45-degree field of view.
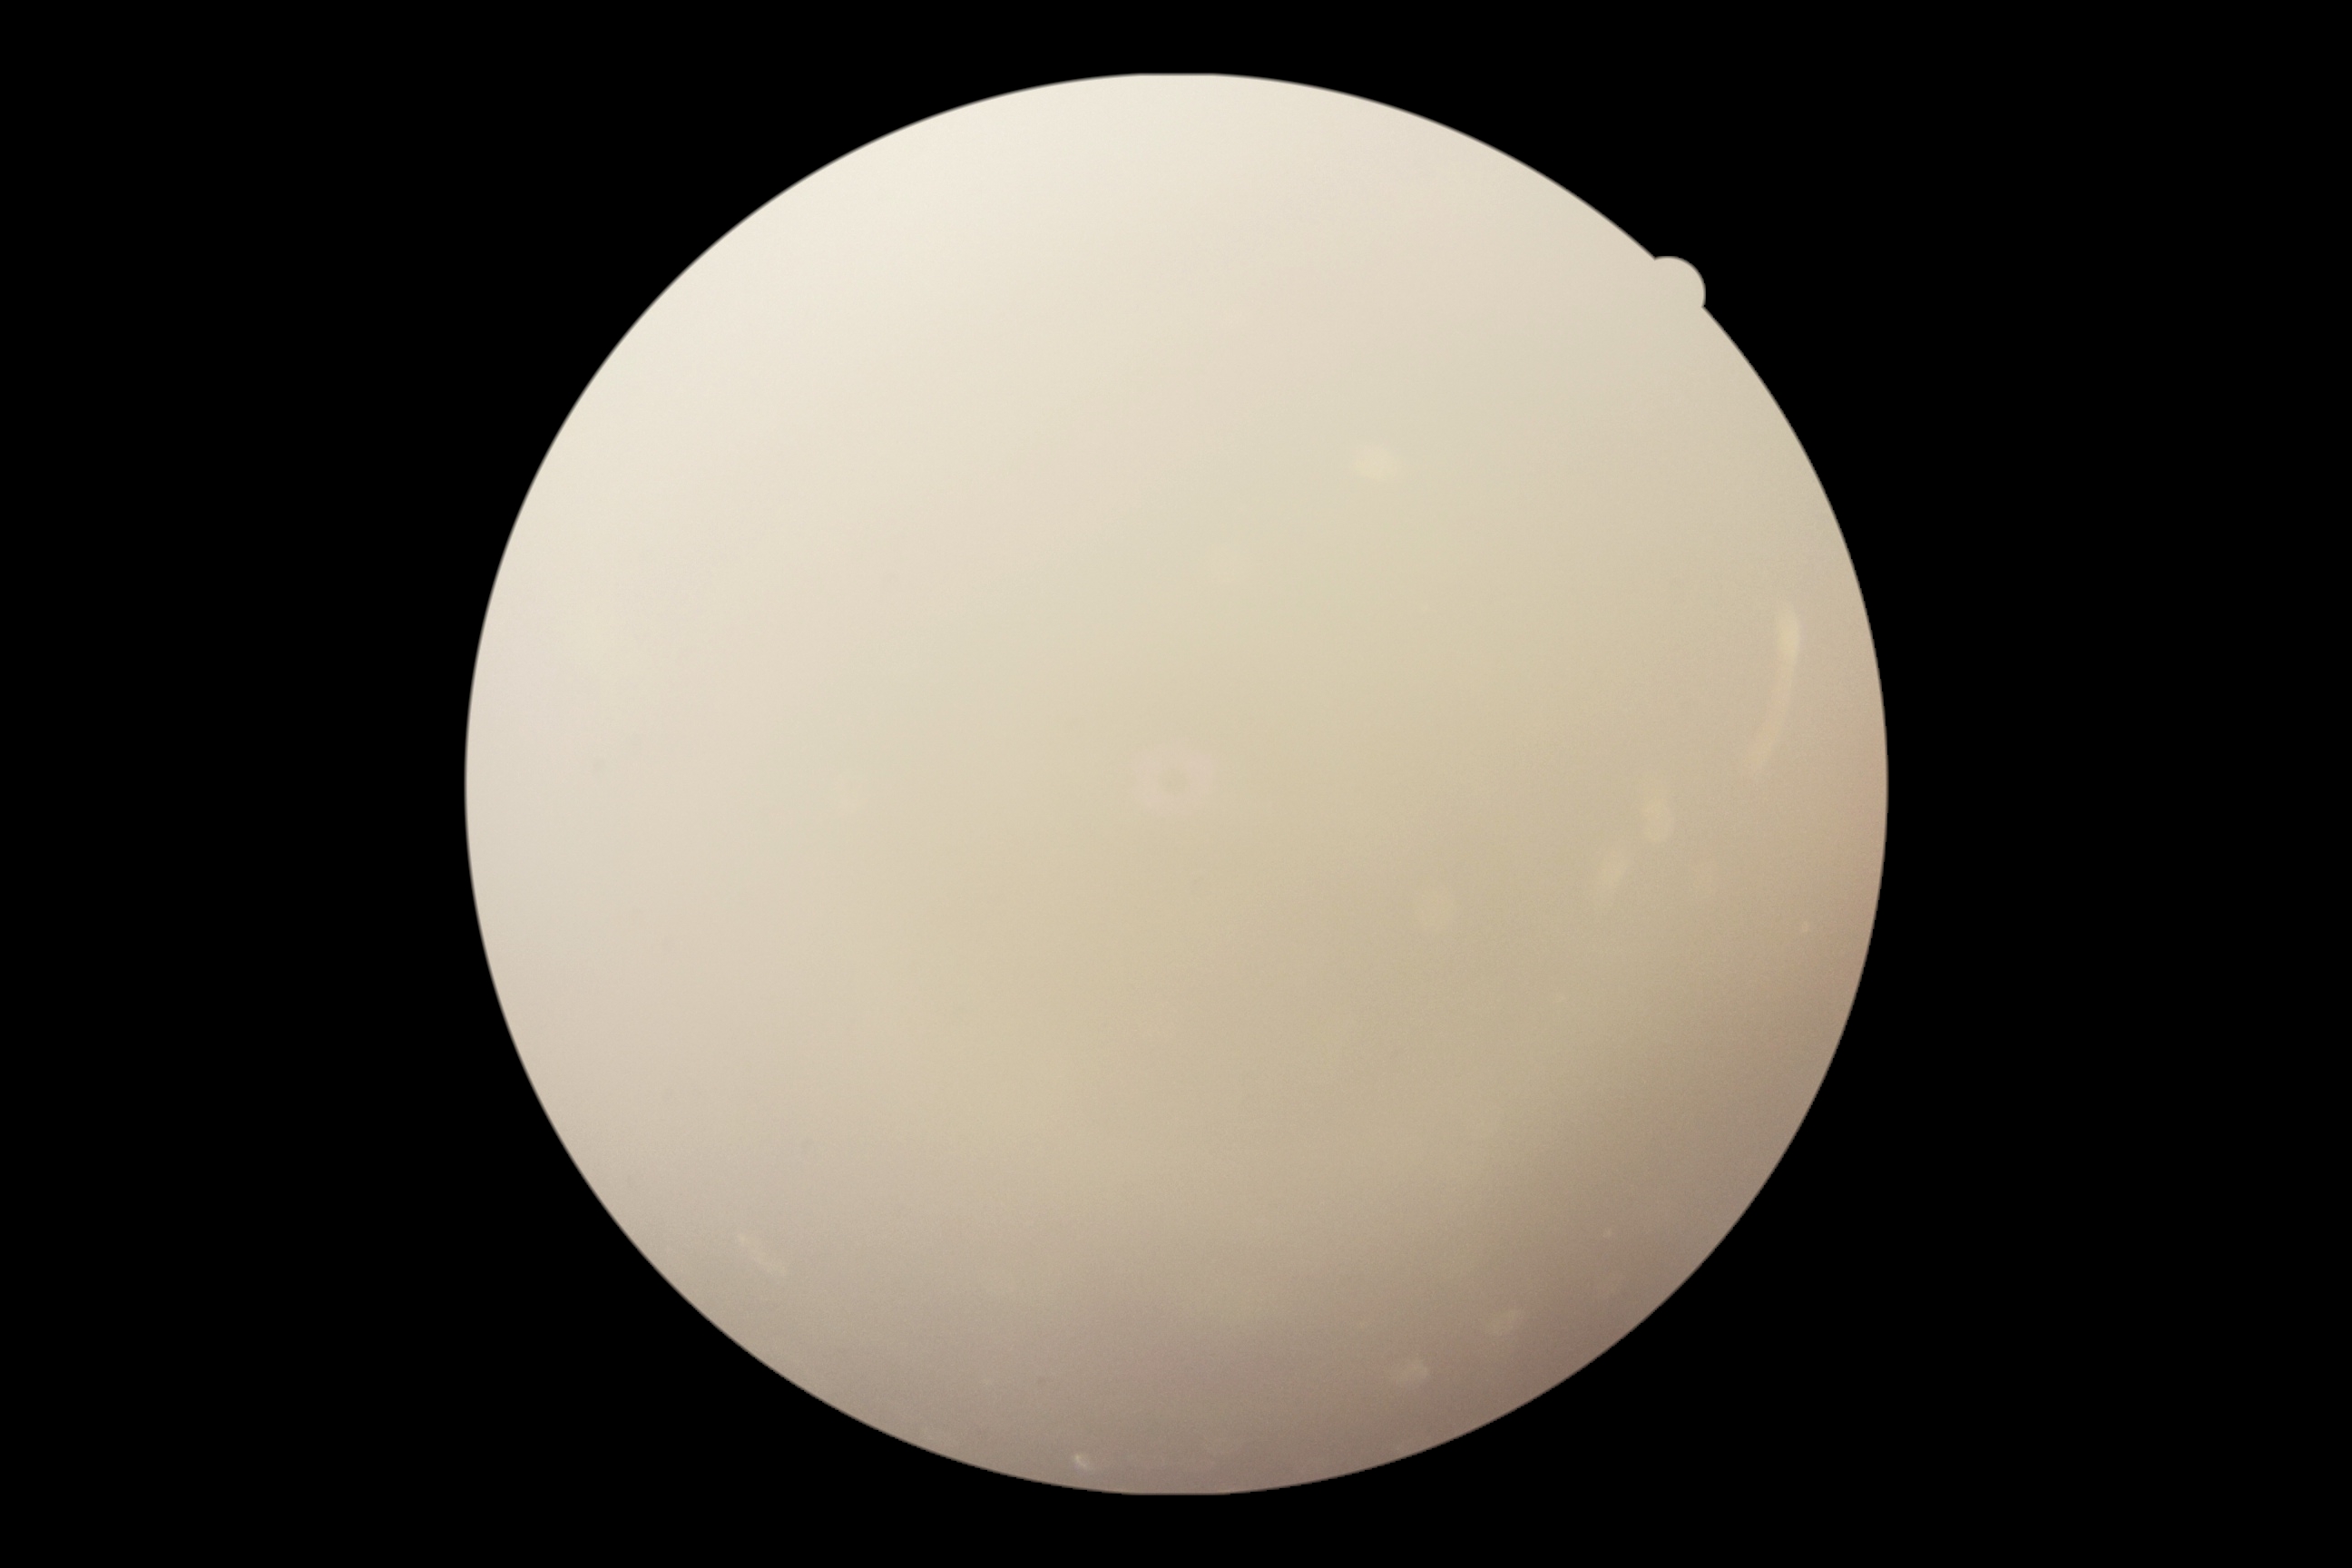

DR grade is ungradable due to poor image quality. The image cannot be graded for diabetic retinopathy.